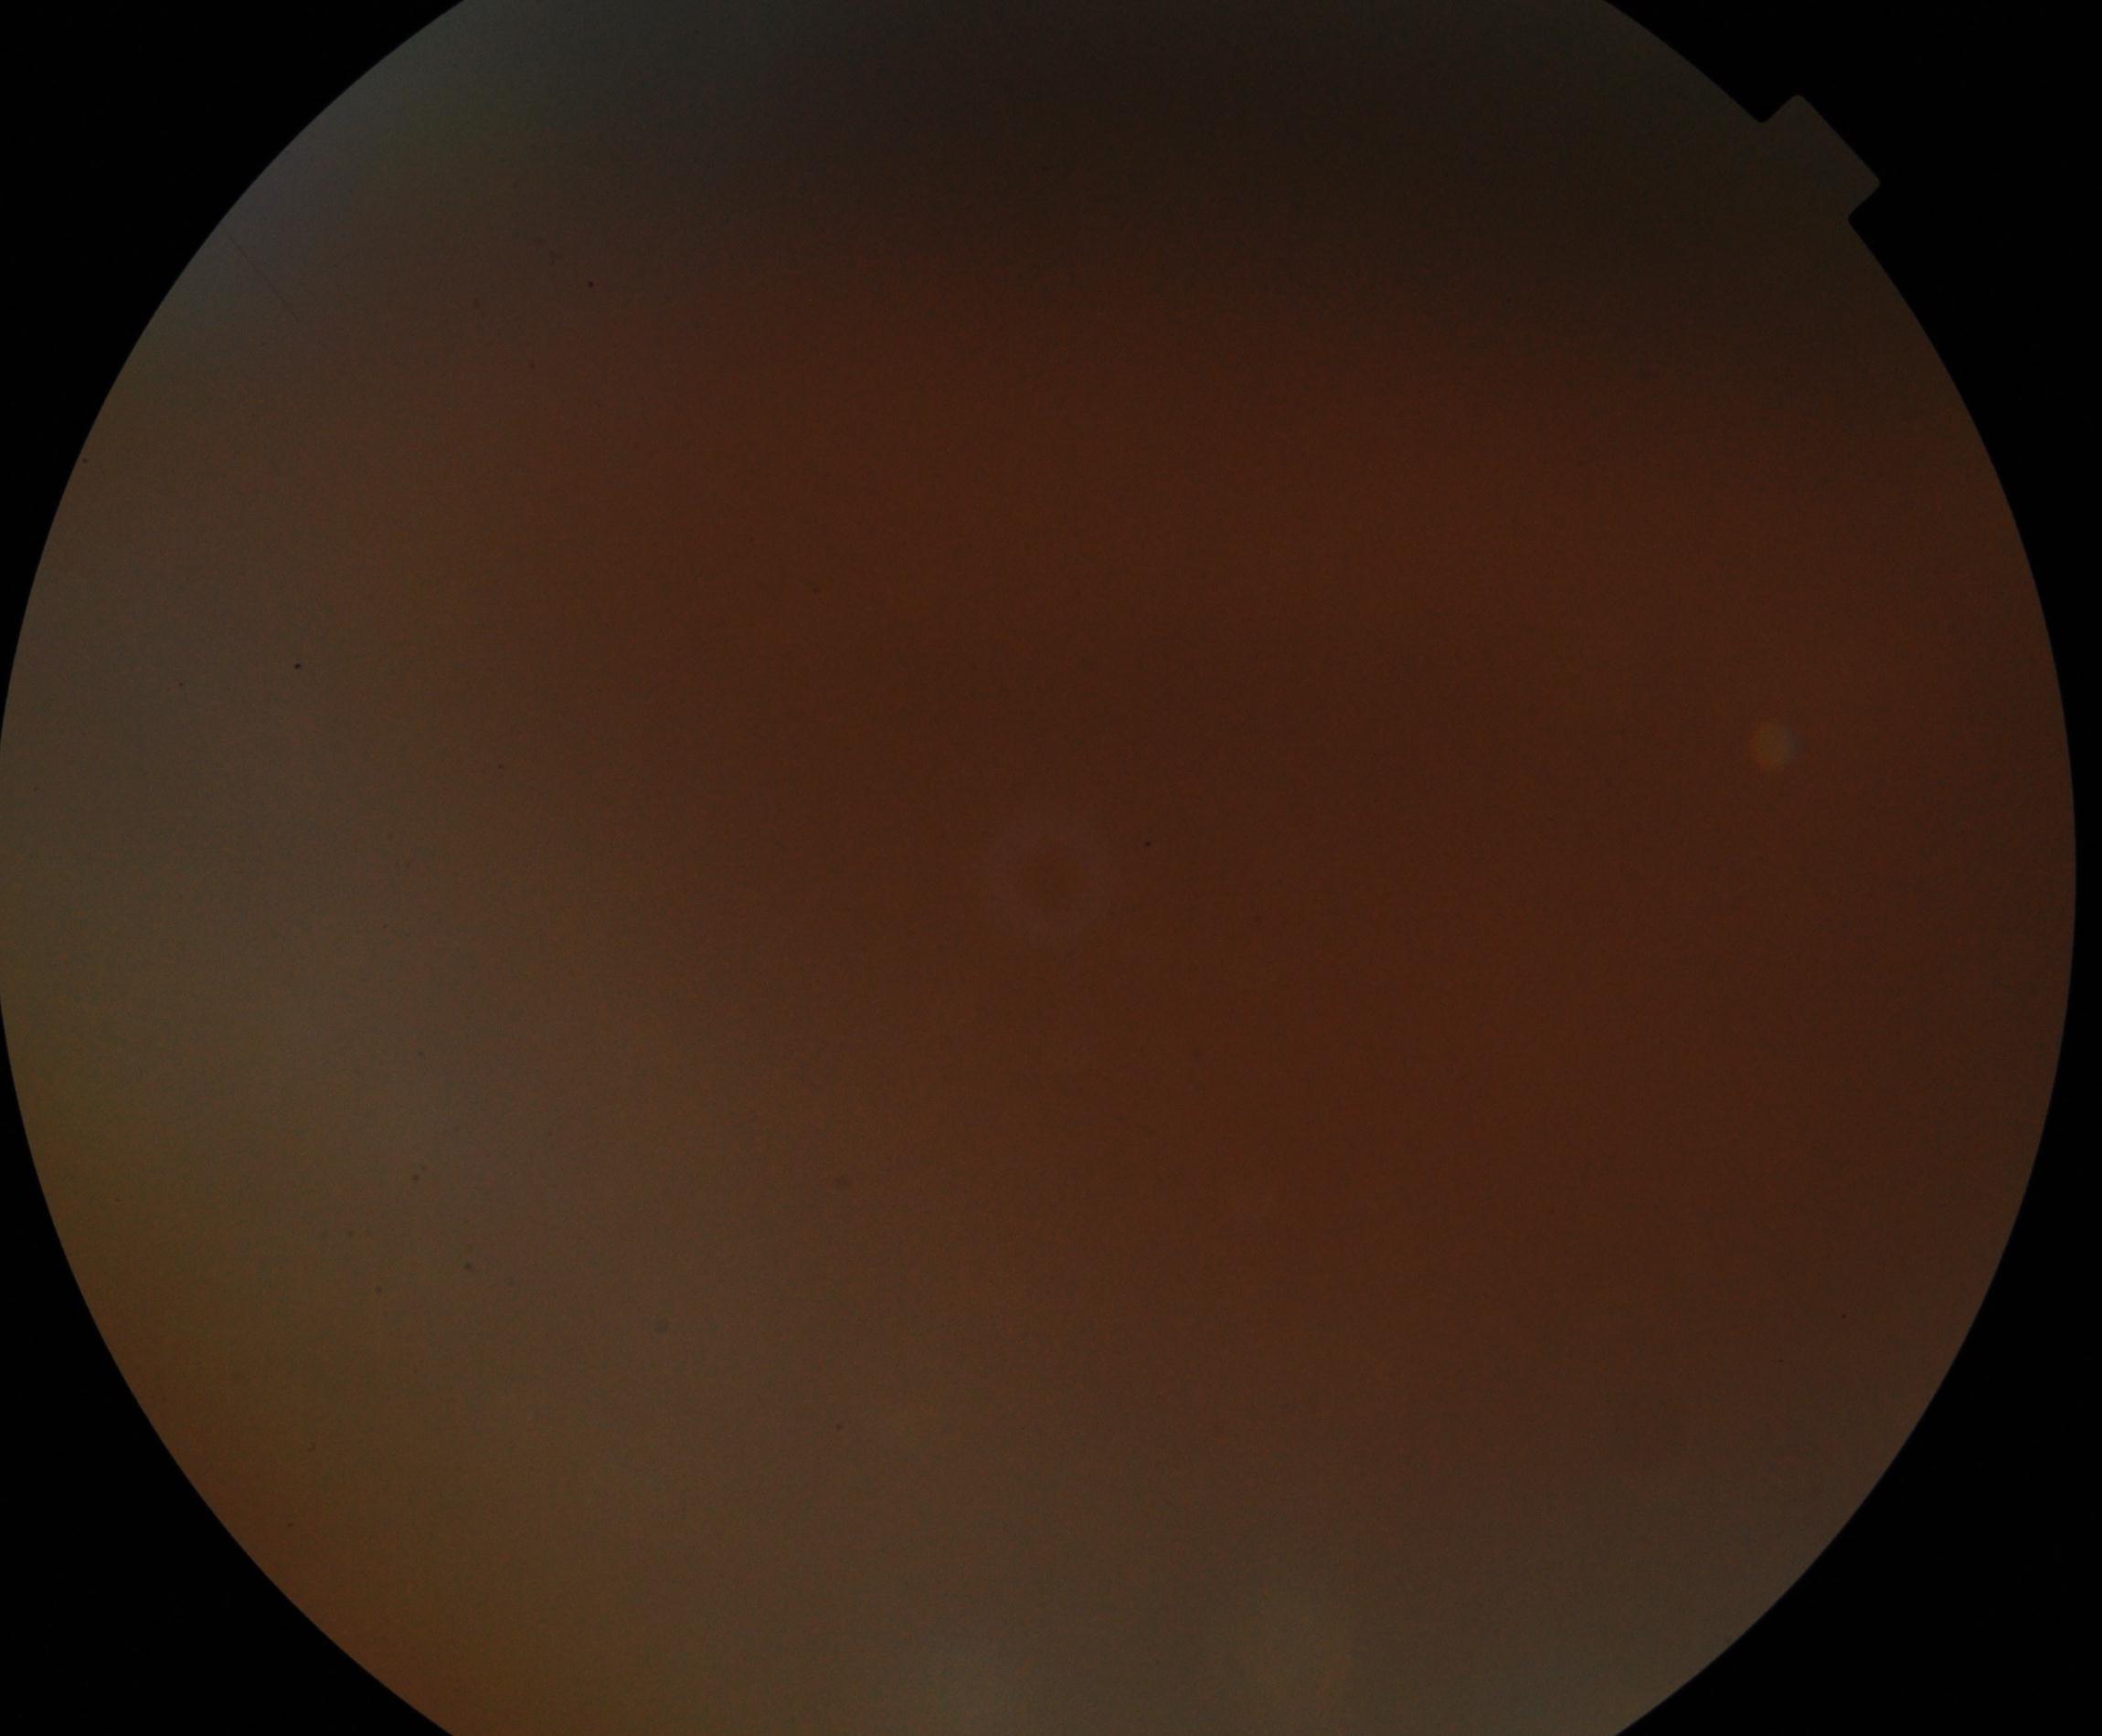

Significantly degraded image quality with obscured retinal detail. No evidence of proliferative diabetic retinopathy.